848x848; no pharmacologic dilation: 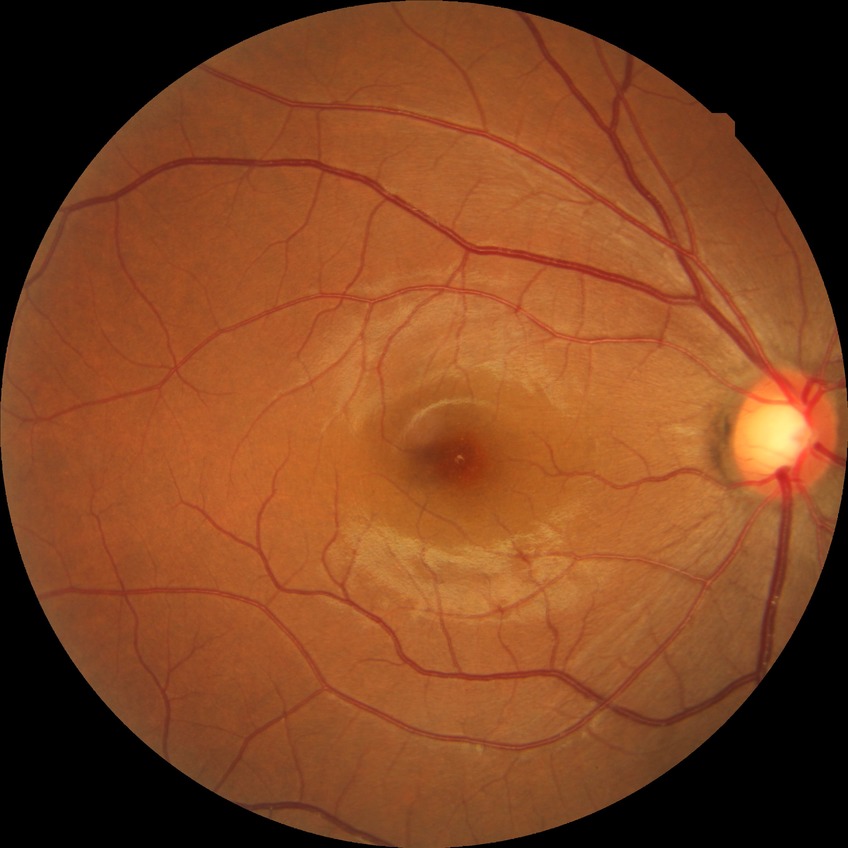

Diabetic retinopathy (DR) is NDR (no diabetic retinopathy).